1924x1556 · ultra-widefield fundus mosaic
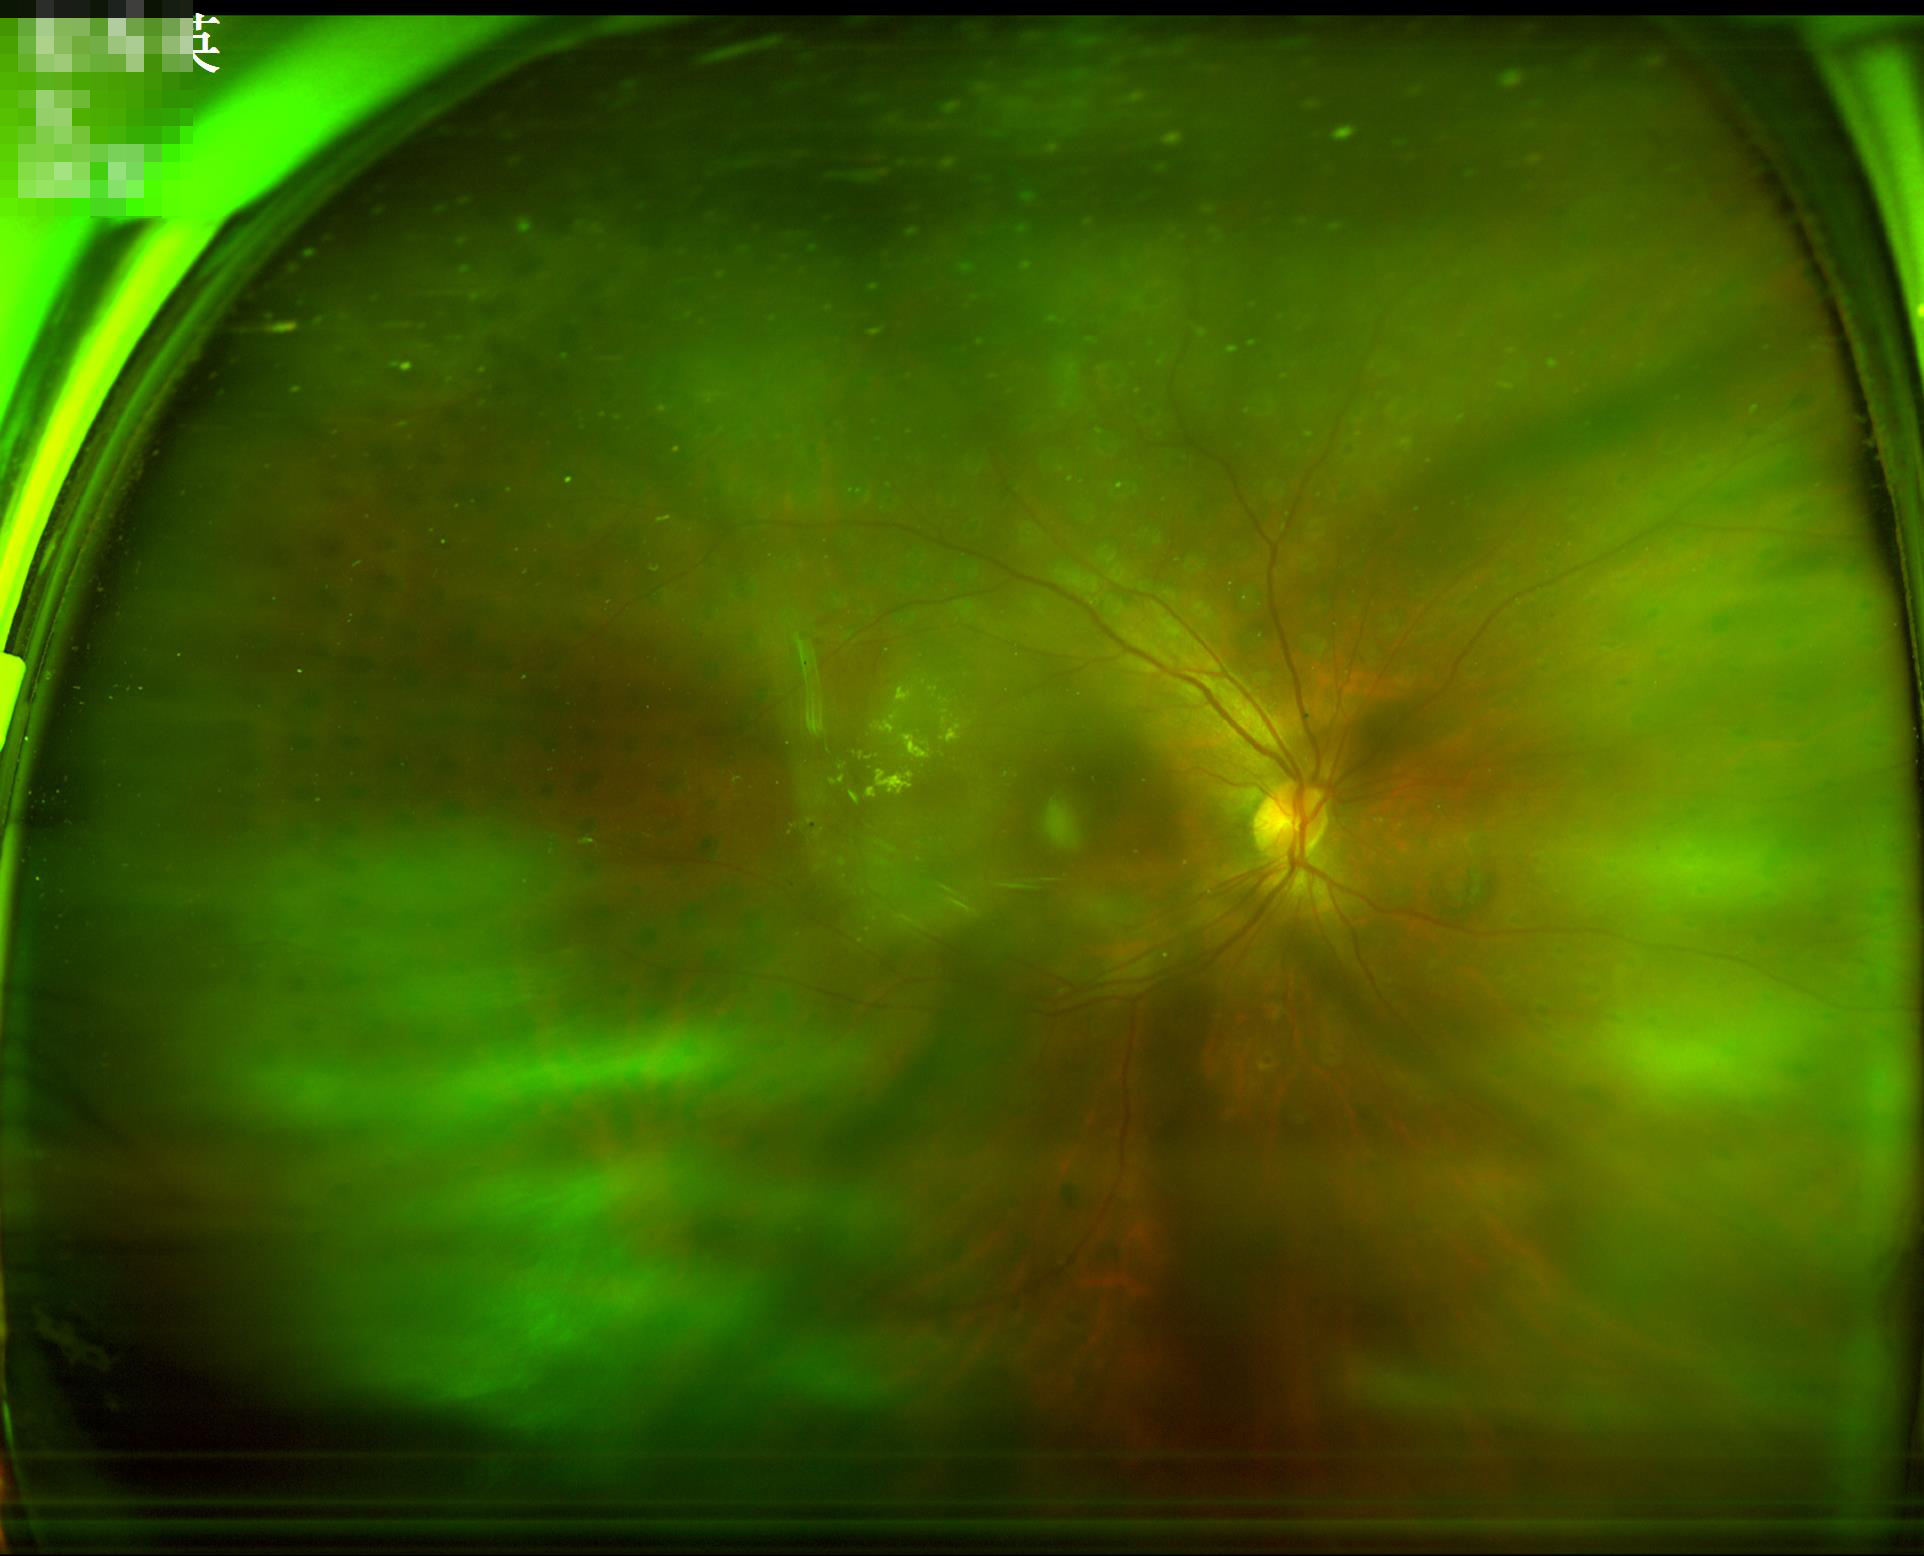
Overall quality is poor; the image is difficult to grade. Out of focus; structures are indistinct. Good dynamic range. Poor illumination with uneven exposure.